2352x1568. 45-degree field of view.
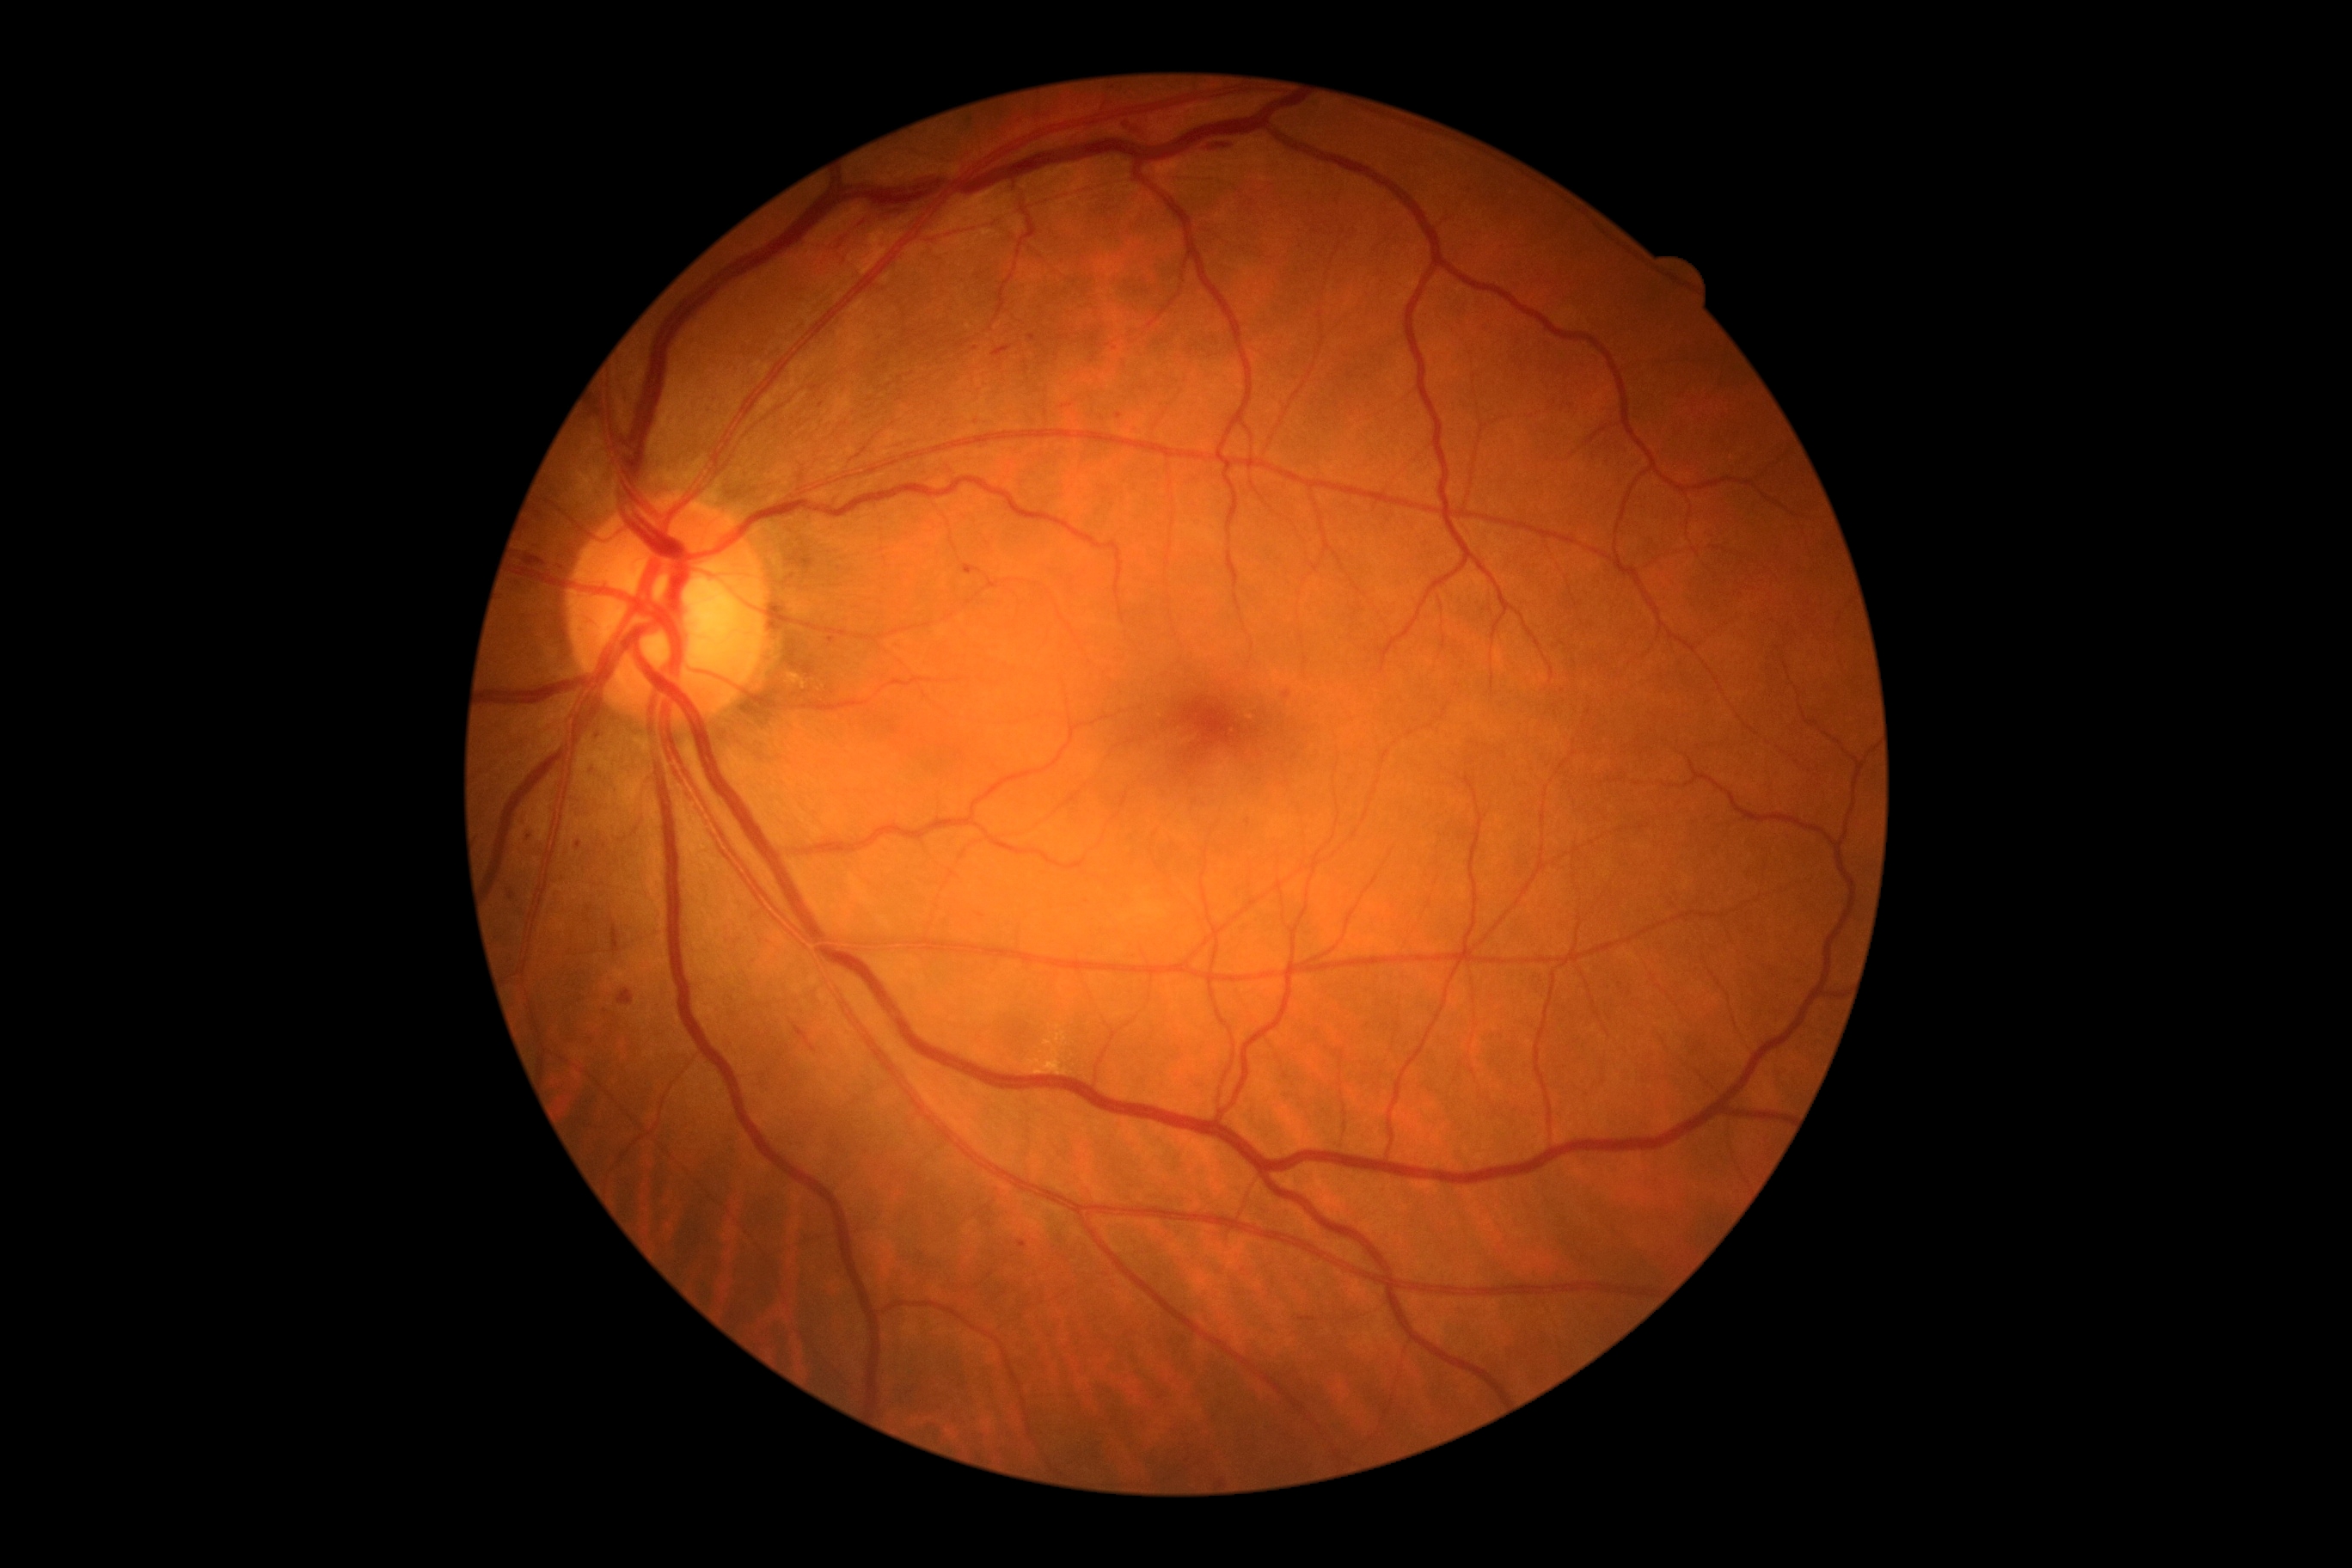 Findings:
- DR severity — grade 2